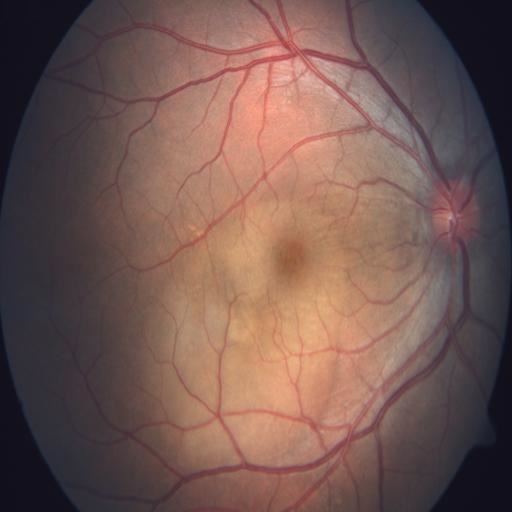

No abnormal findings on fundus examination.